Retinal fundus photograph. 1659 x 2212 pixels.
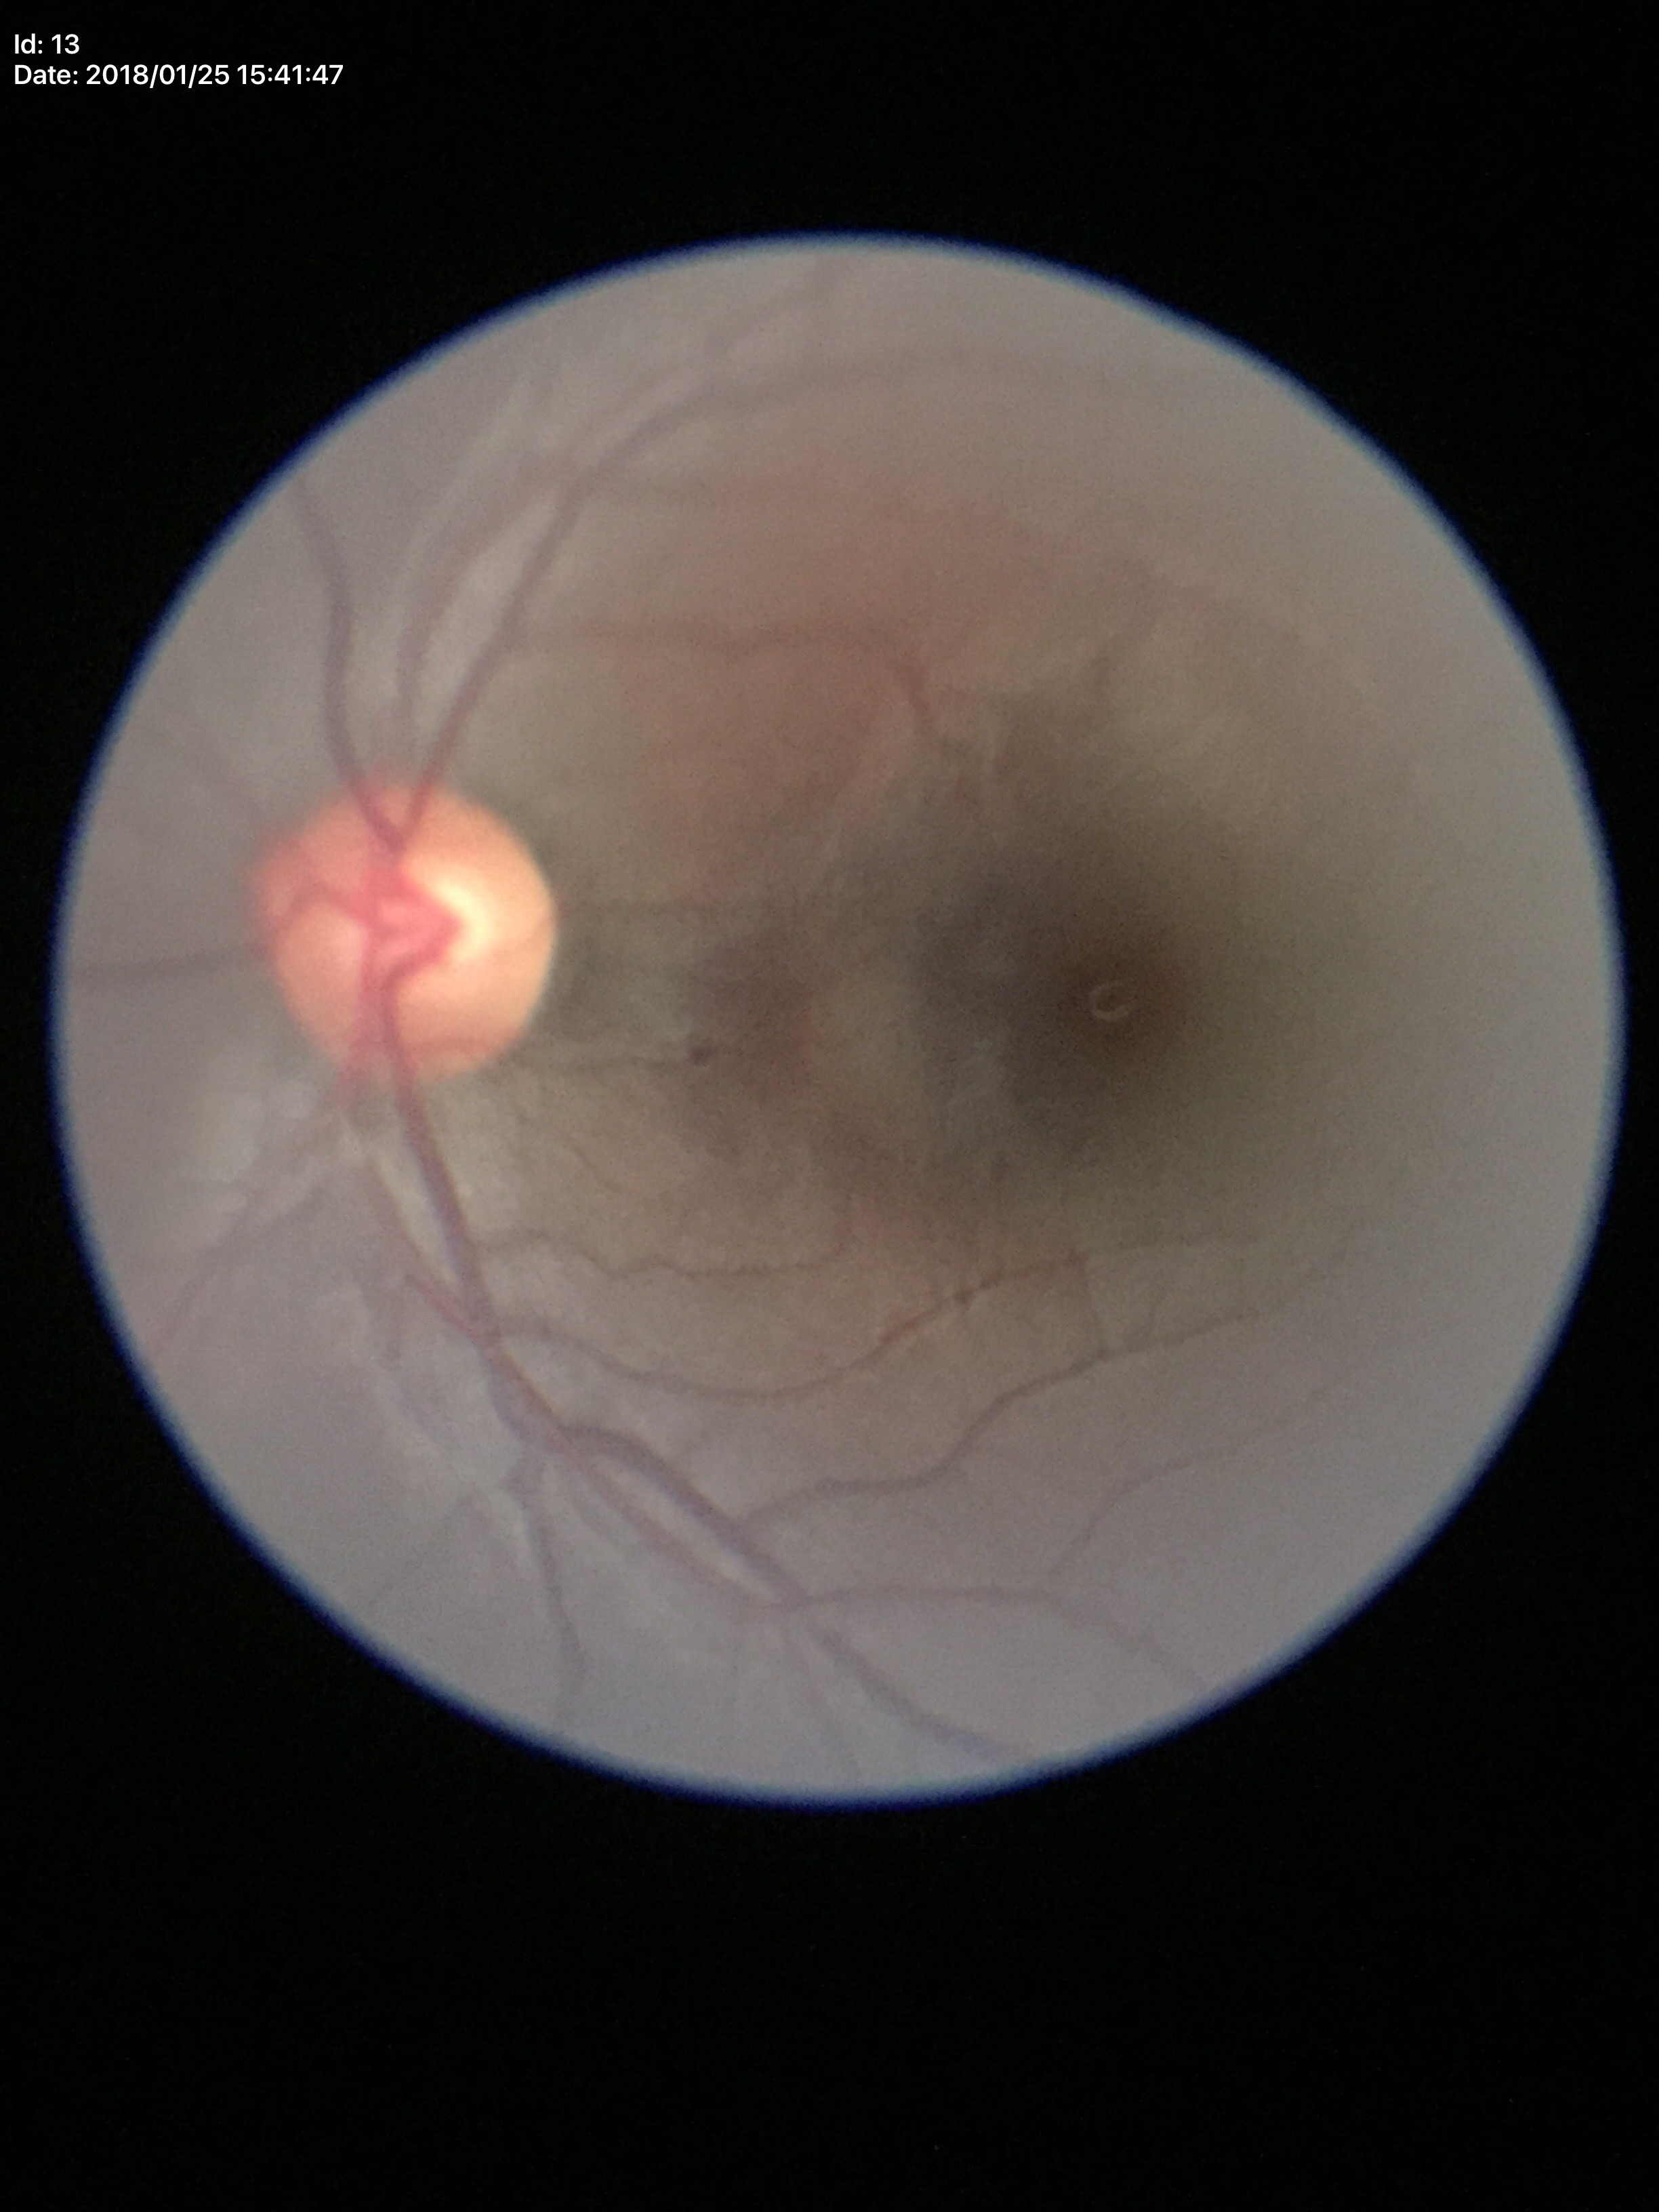 * vertical CDR — 0.51
* Glaucoma screening — negative
* horizontal C/D ratio — 0.56